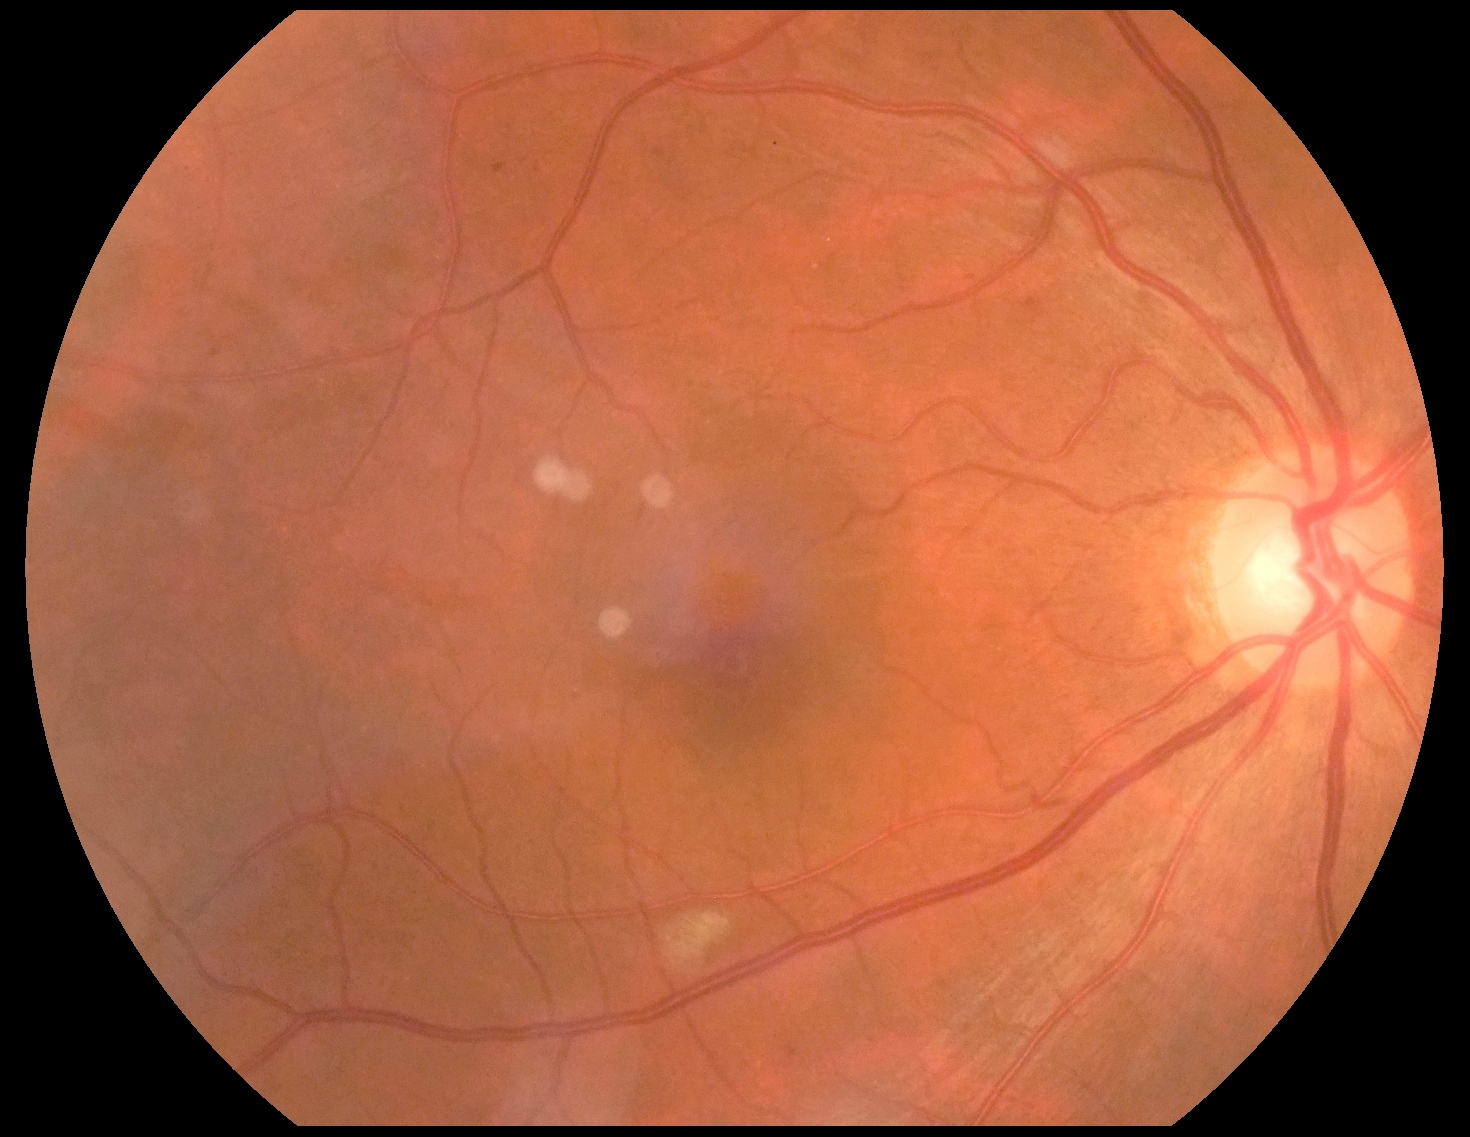

DR grade: 2 (moderate NPDR).